200° FOV · wide-field retinal mosaic image: 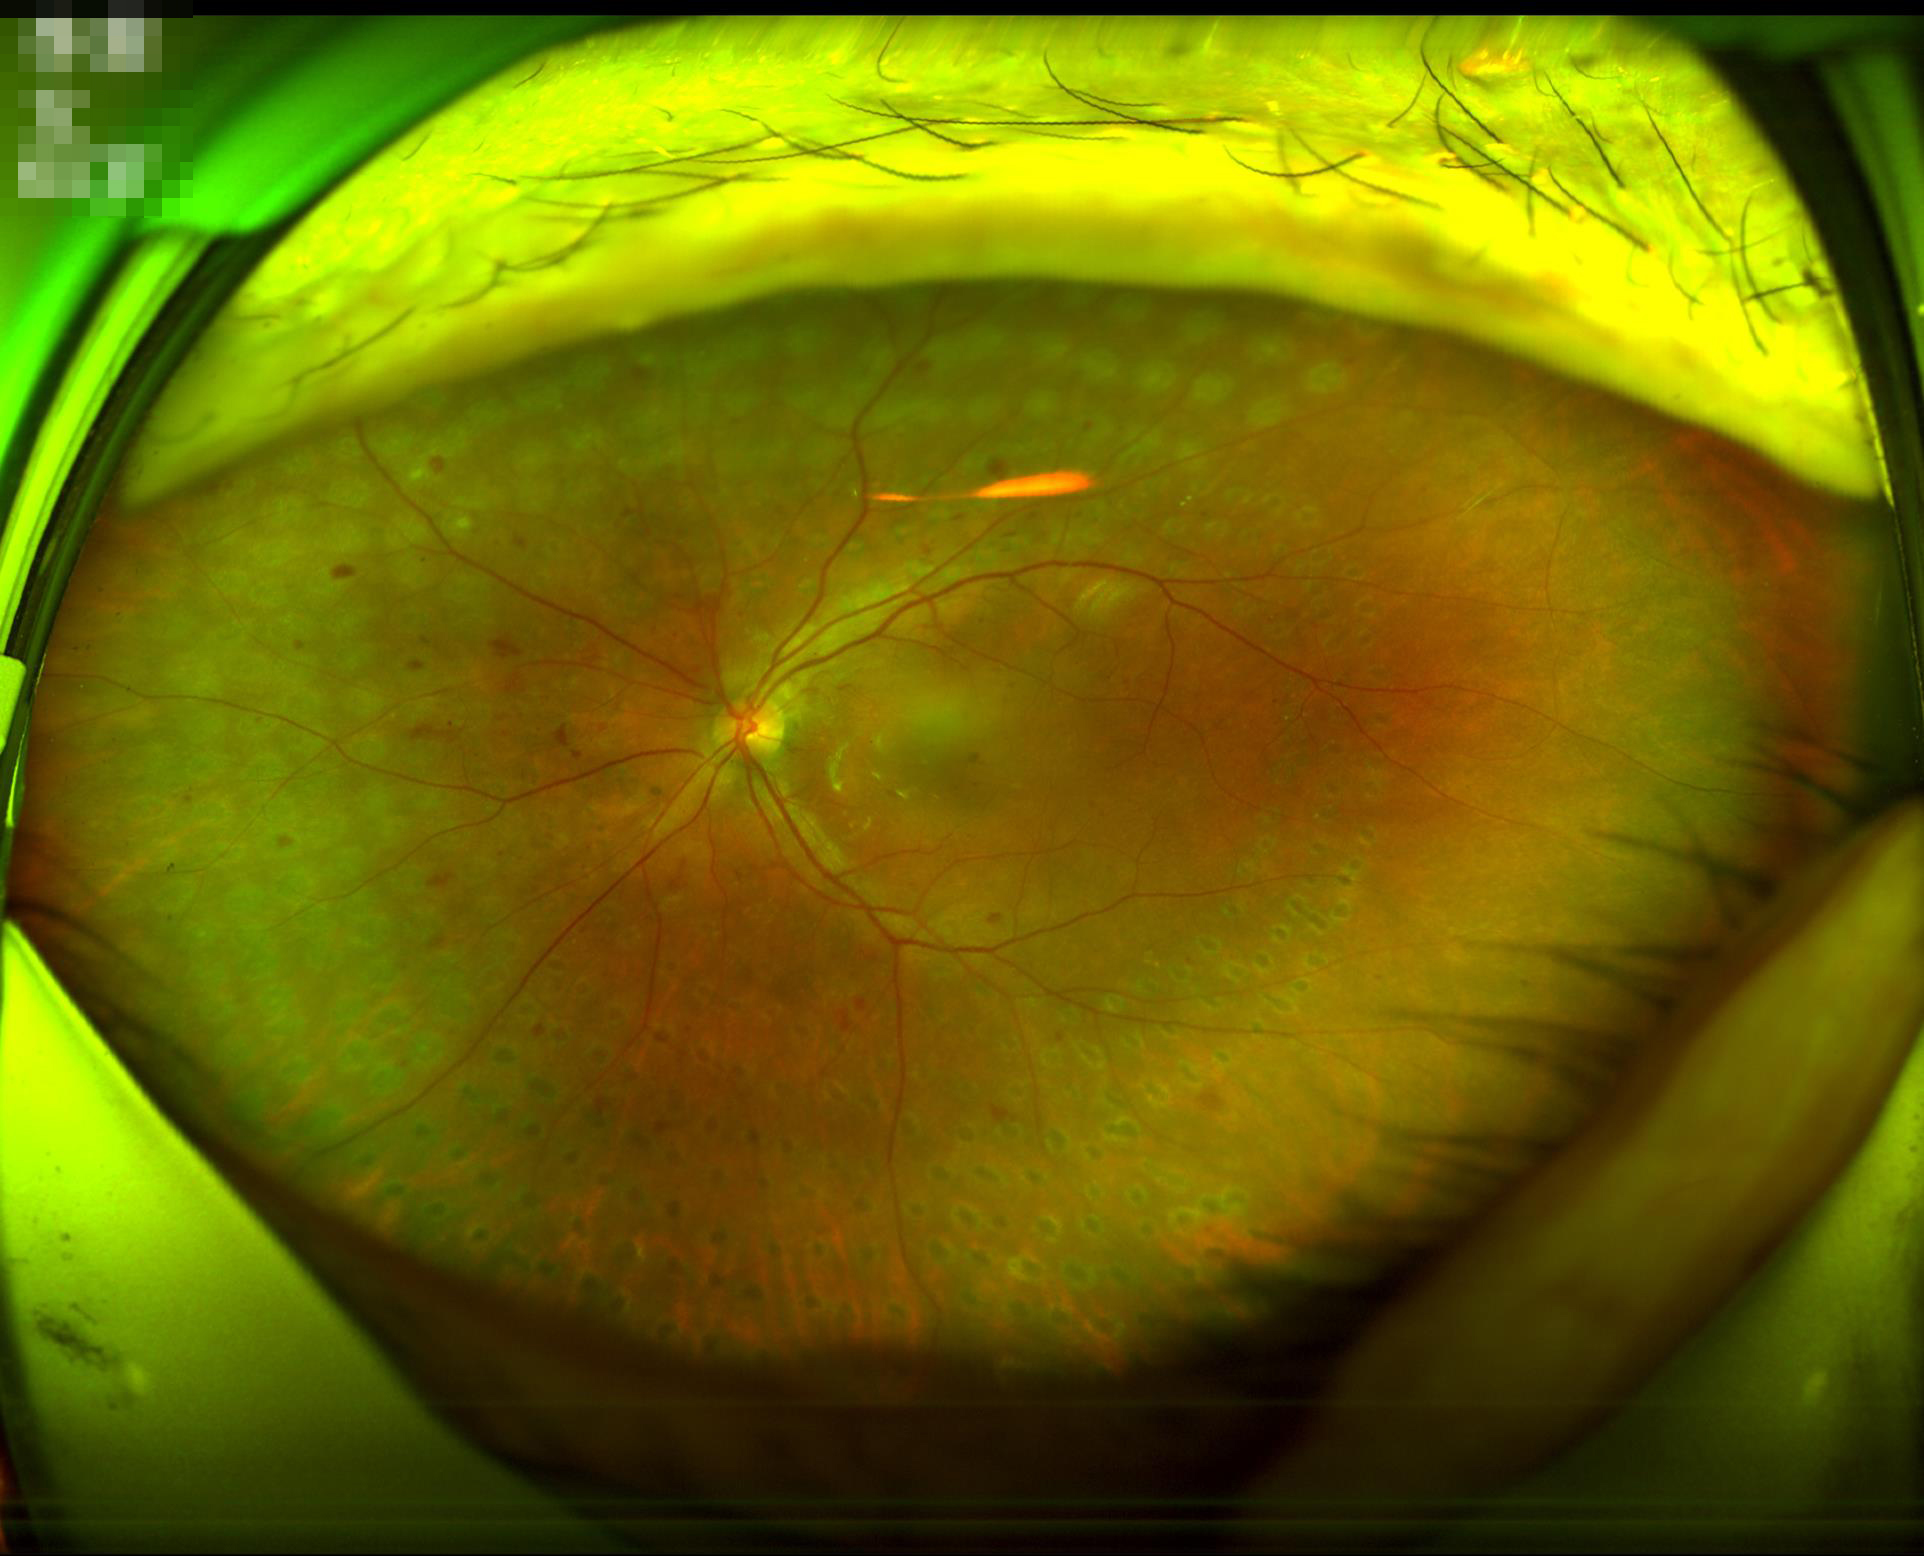

Illumination is even. Acceptable image quality.